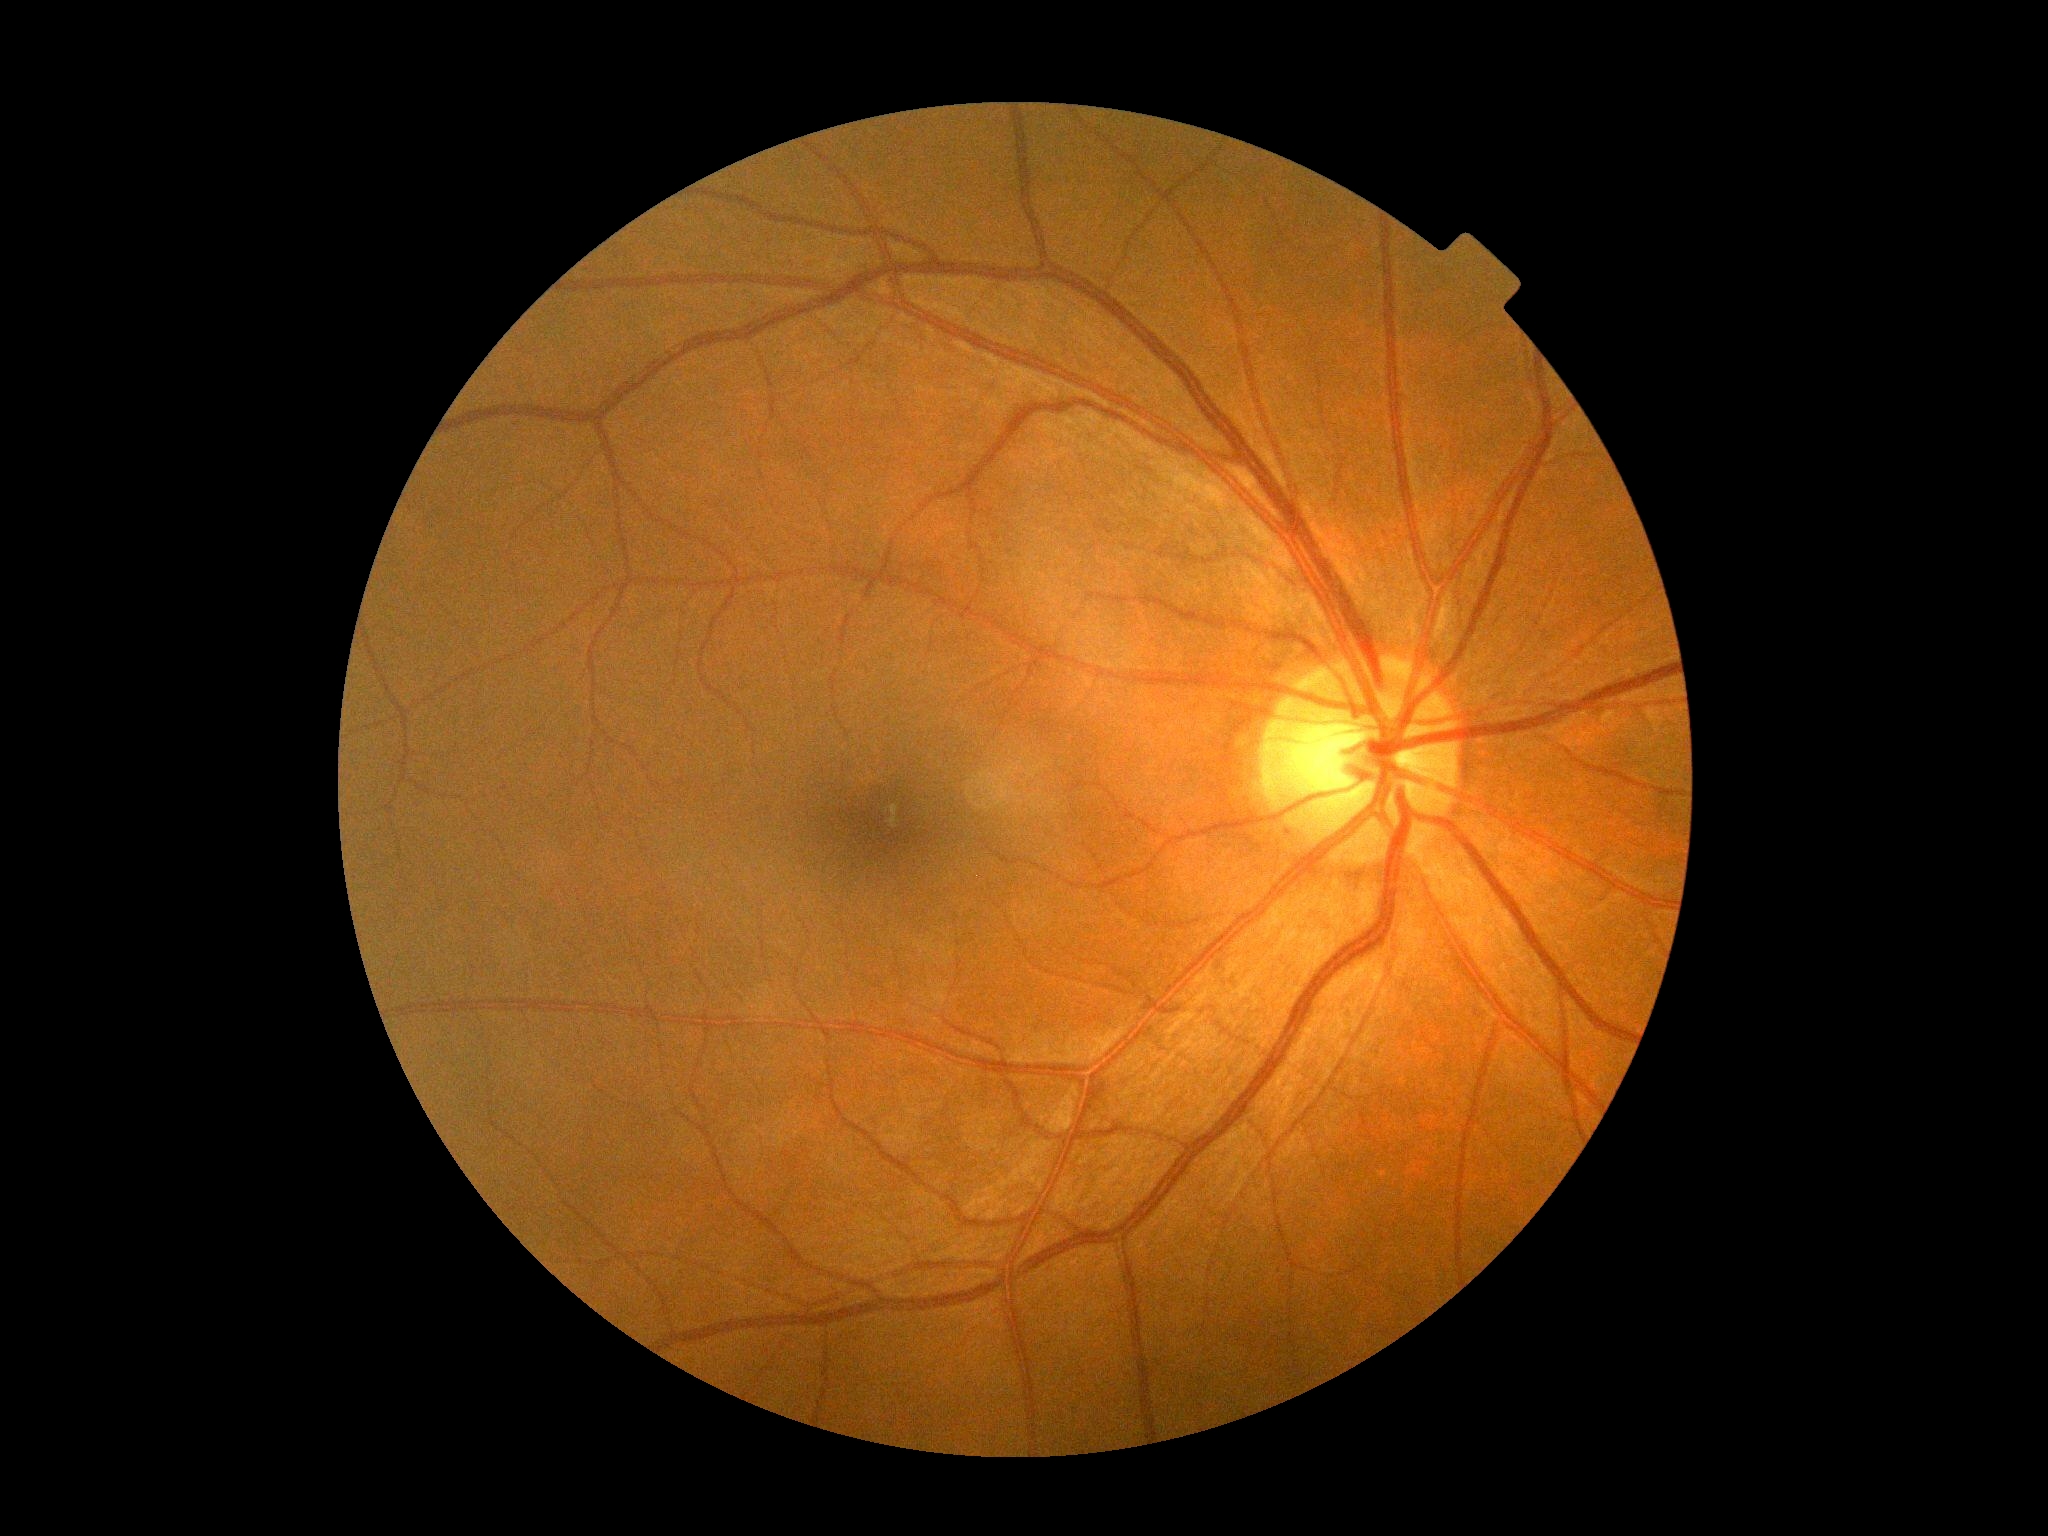
Diabetic retinopathy grade: 0/4.